Camera: NIDEK AFC-230. 45° FOV
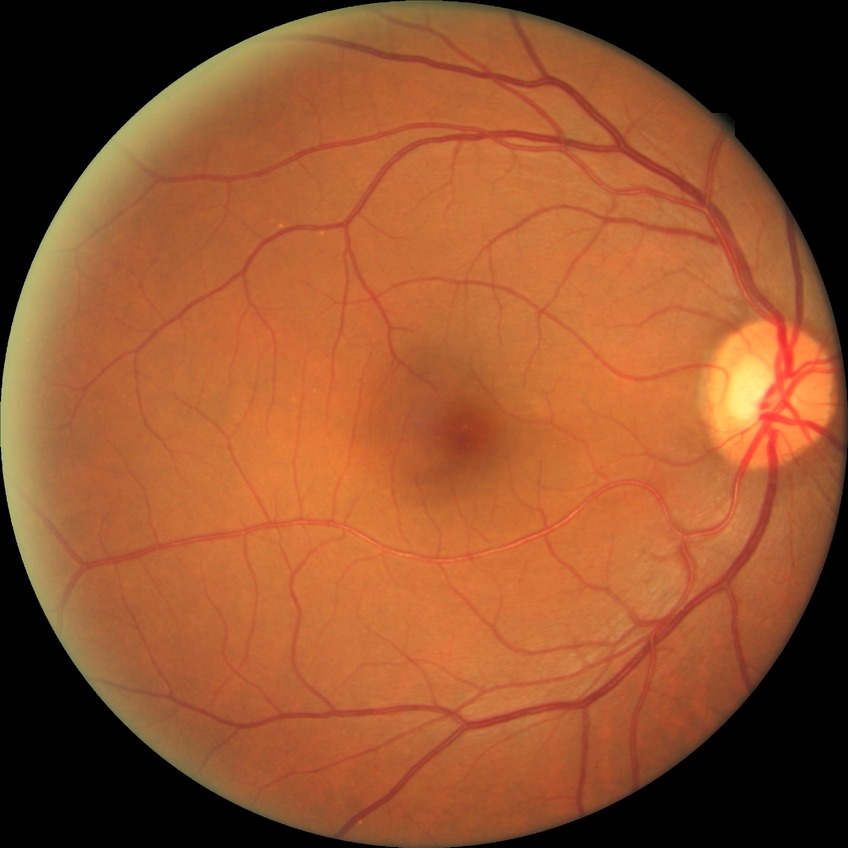

Diabetic retinopathy (DR) is no diabetic retinopathy (NDR).